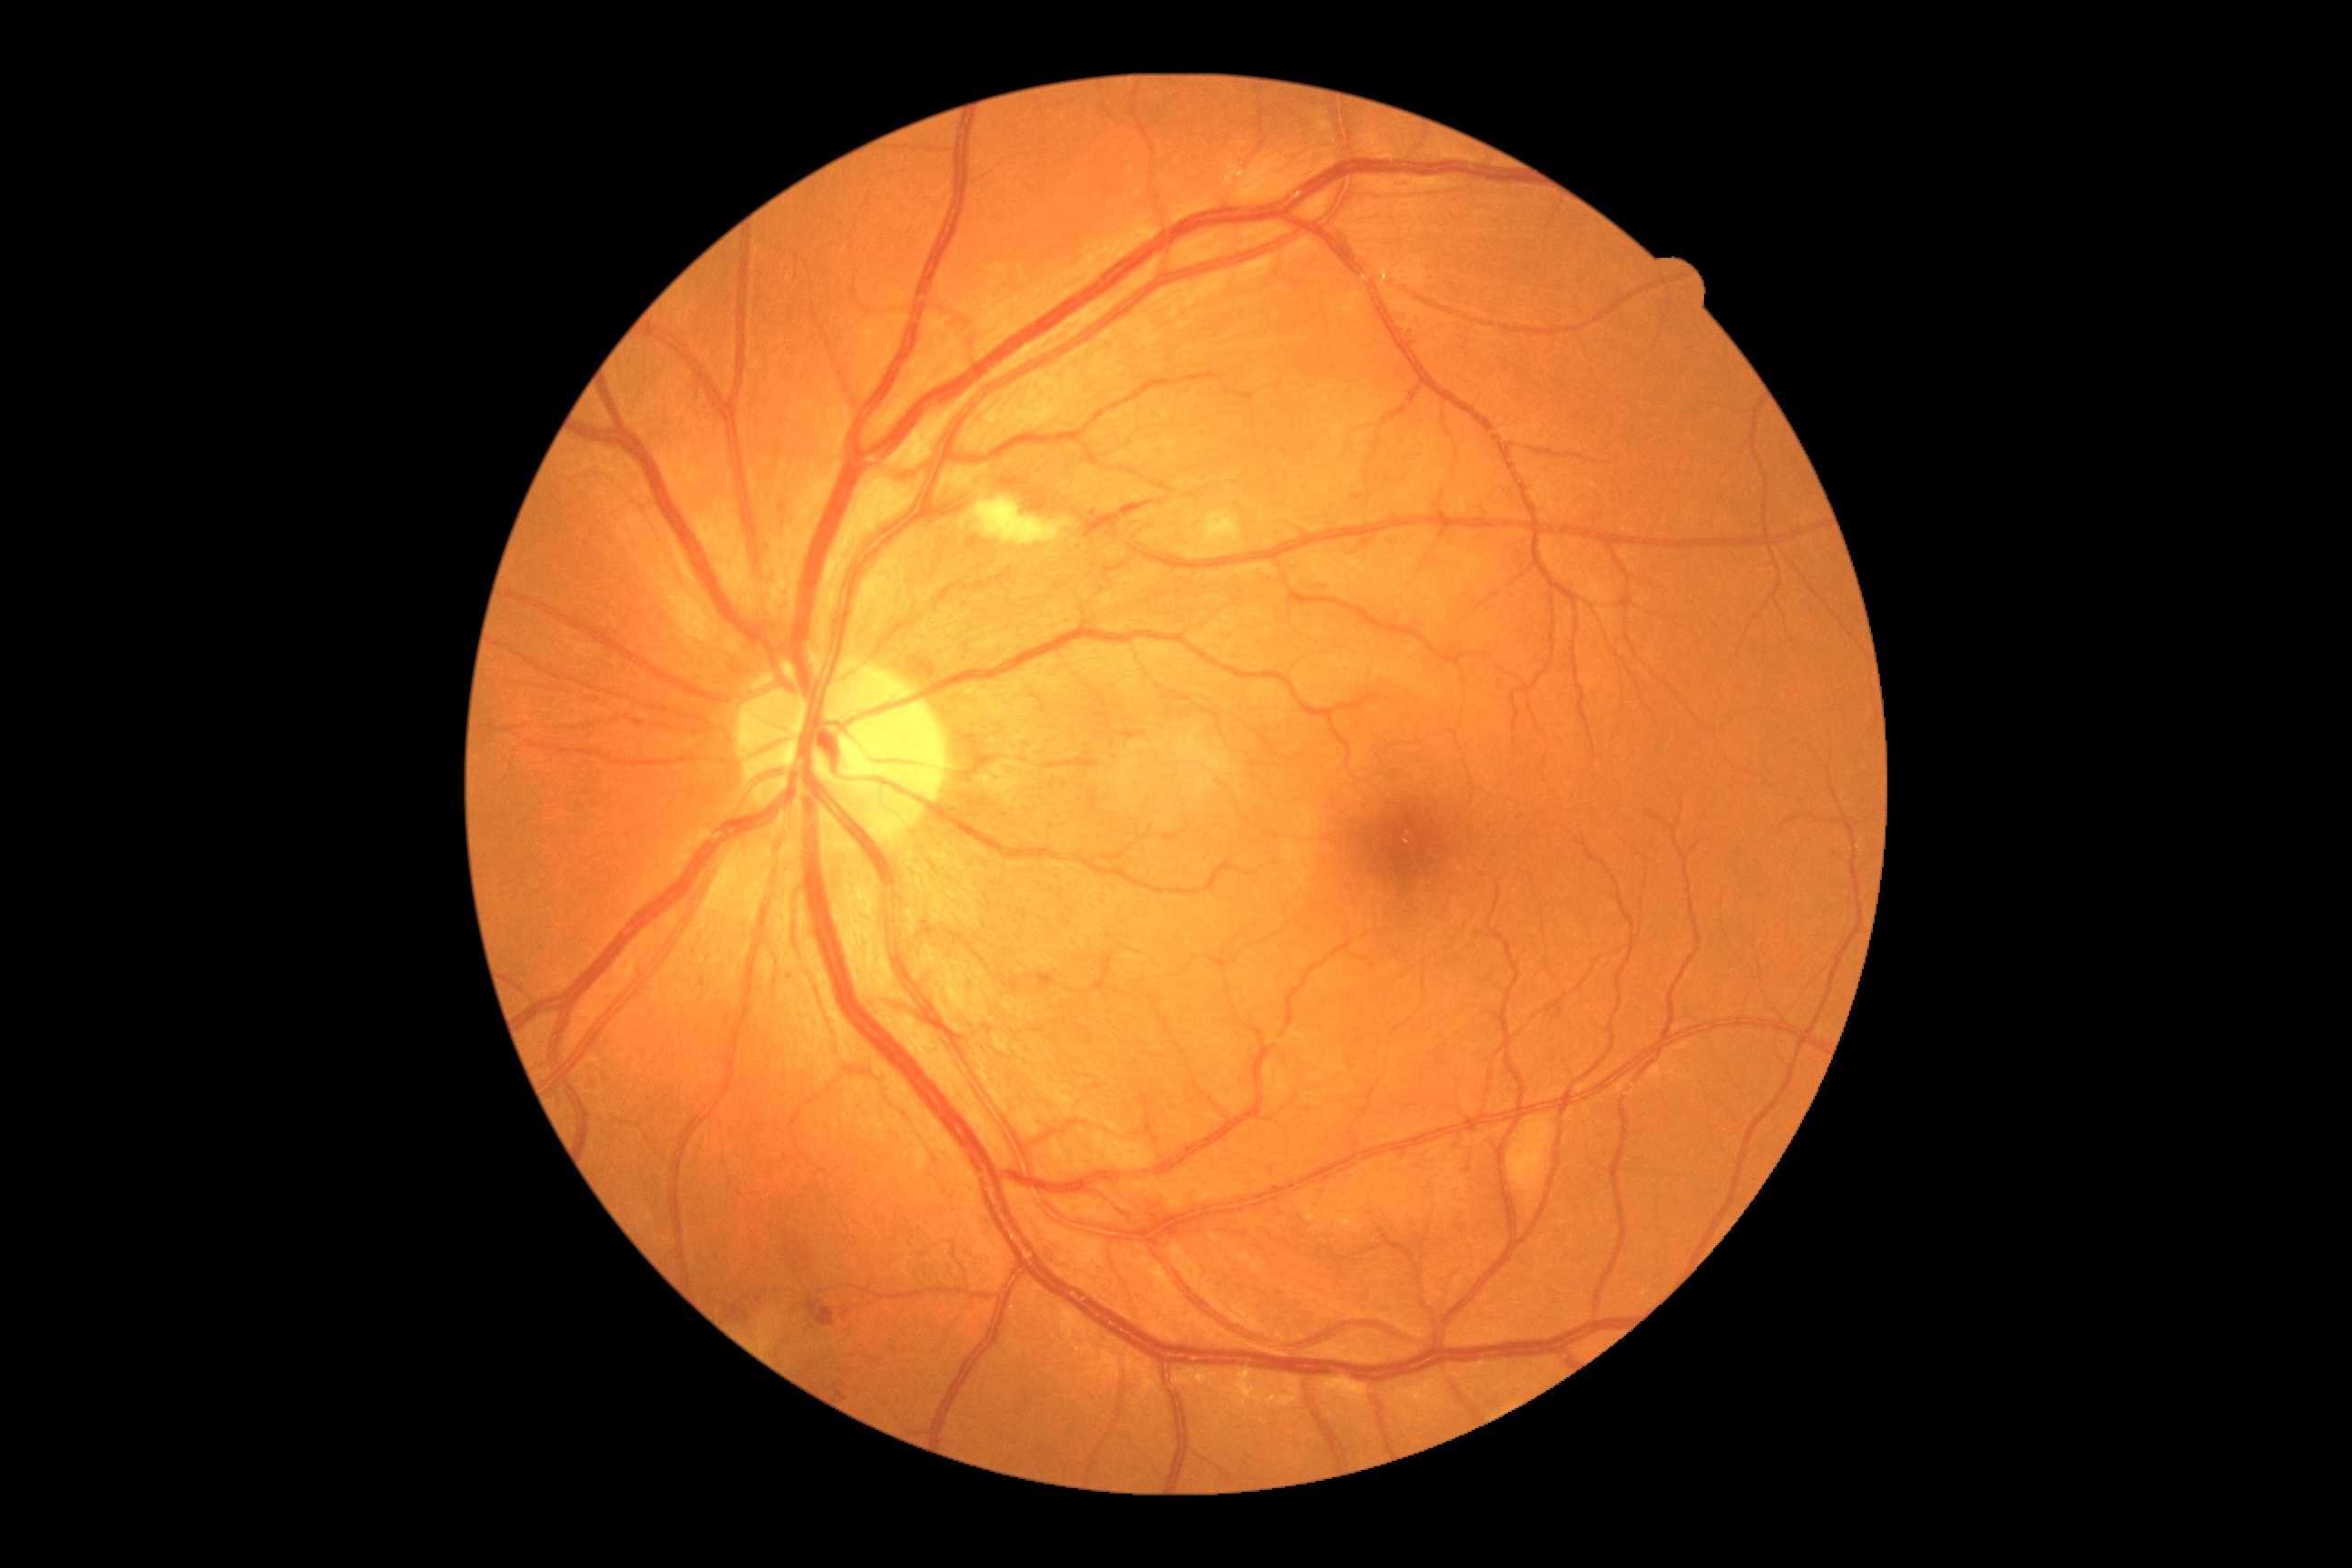

DR grade: 2.